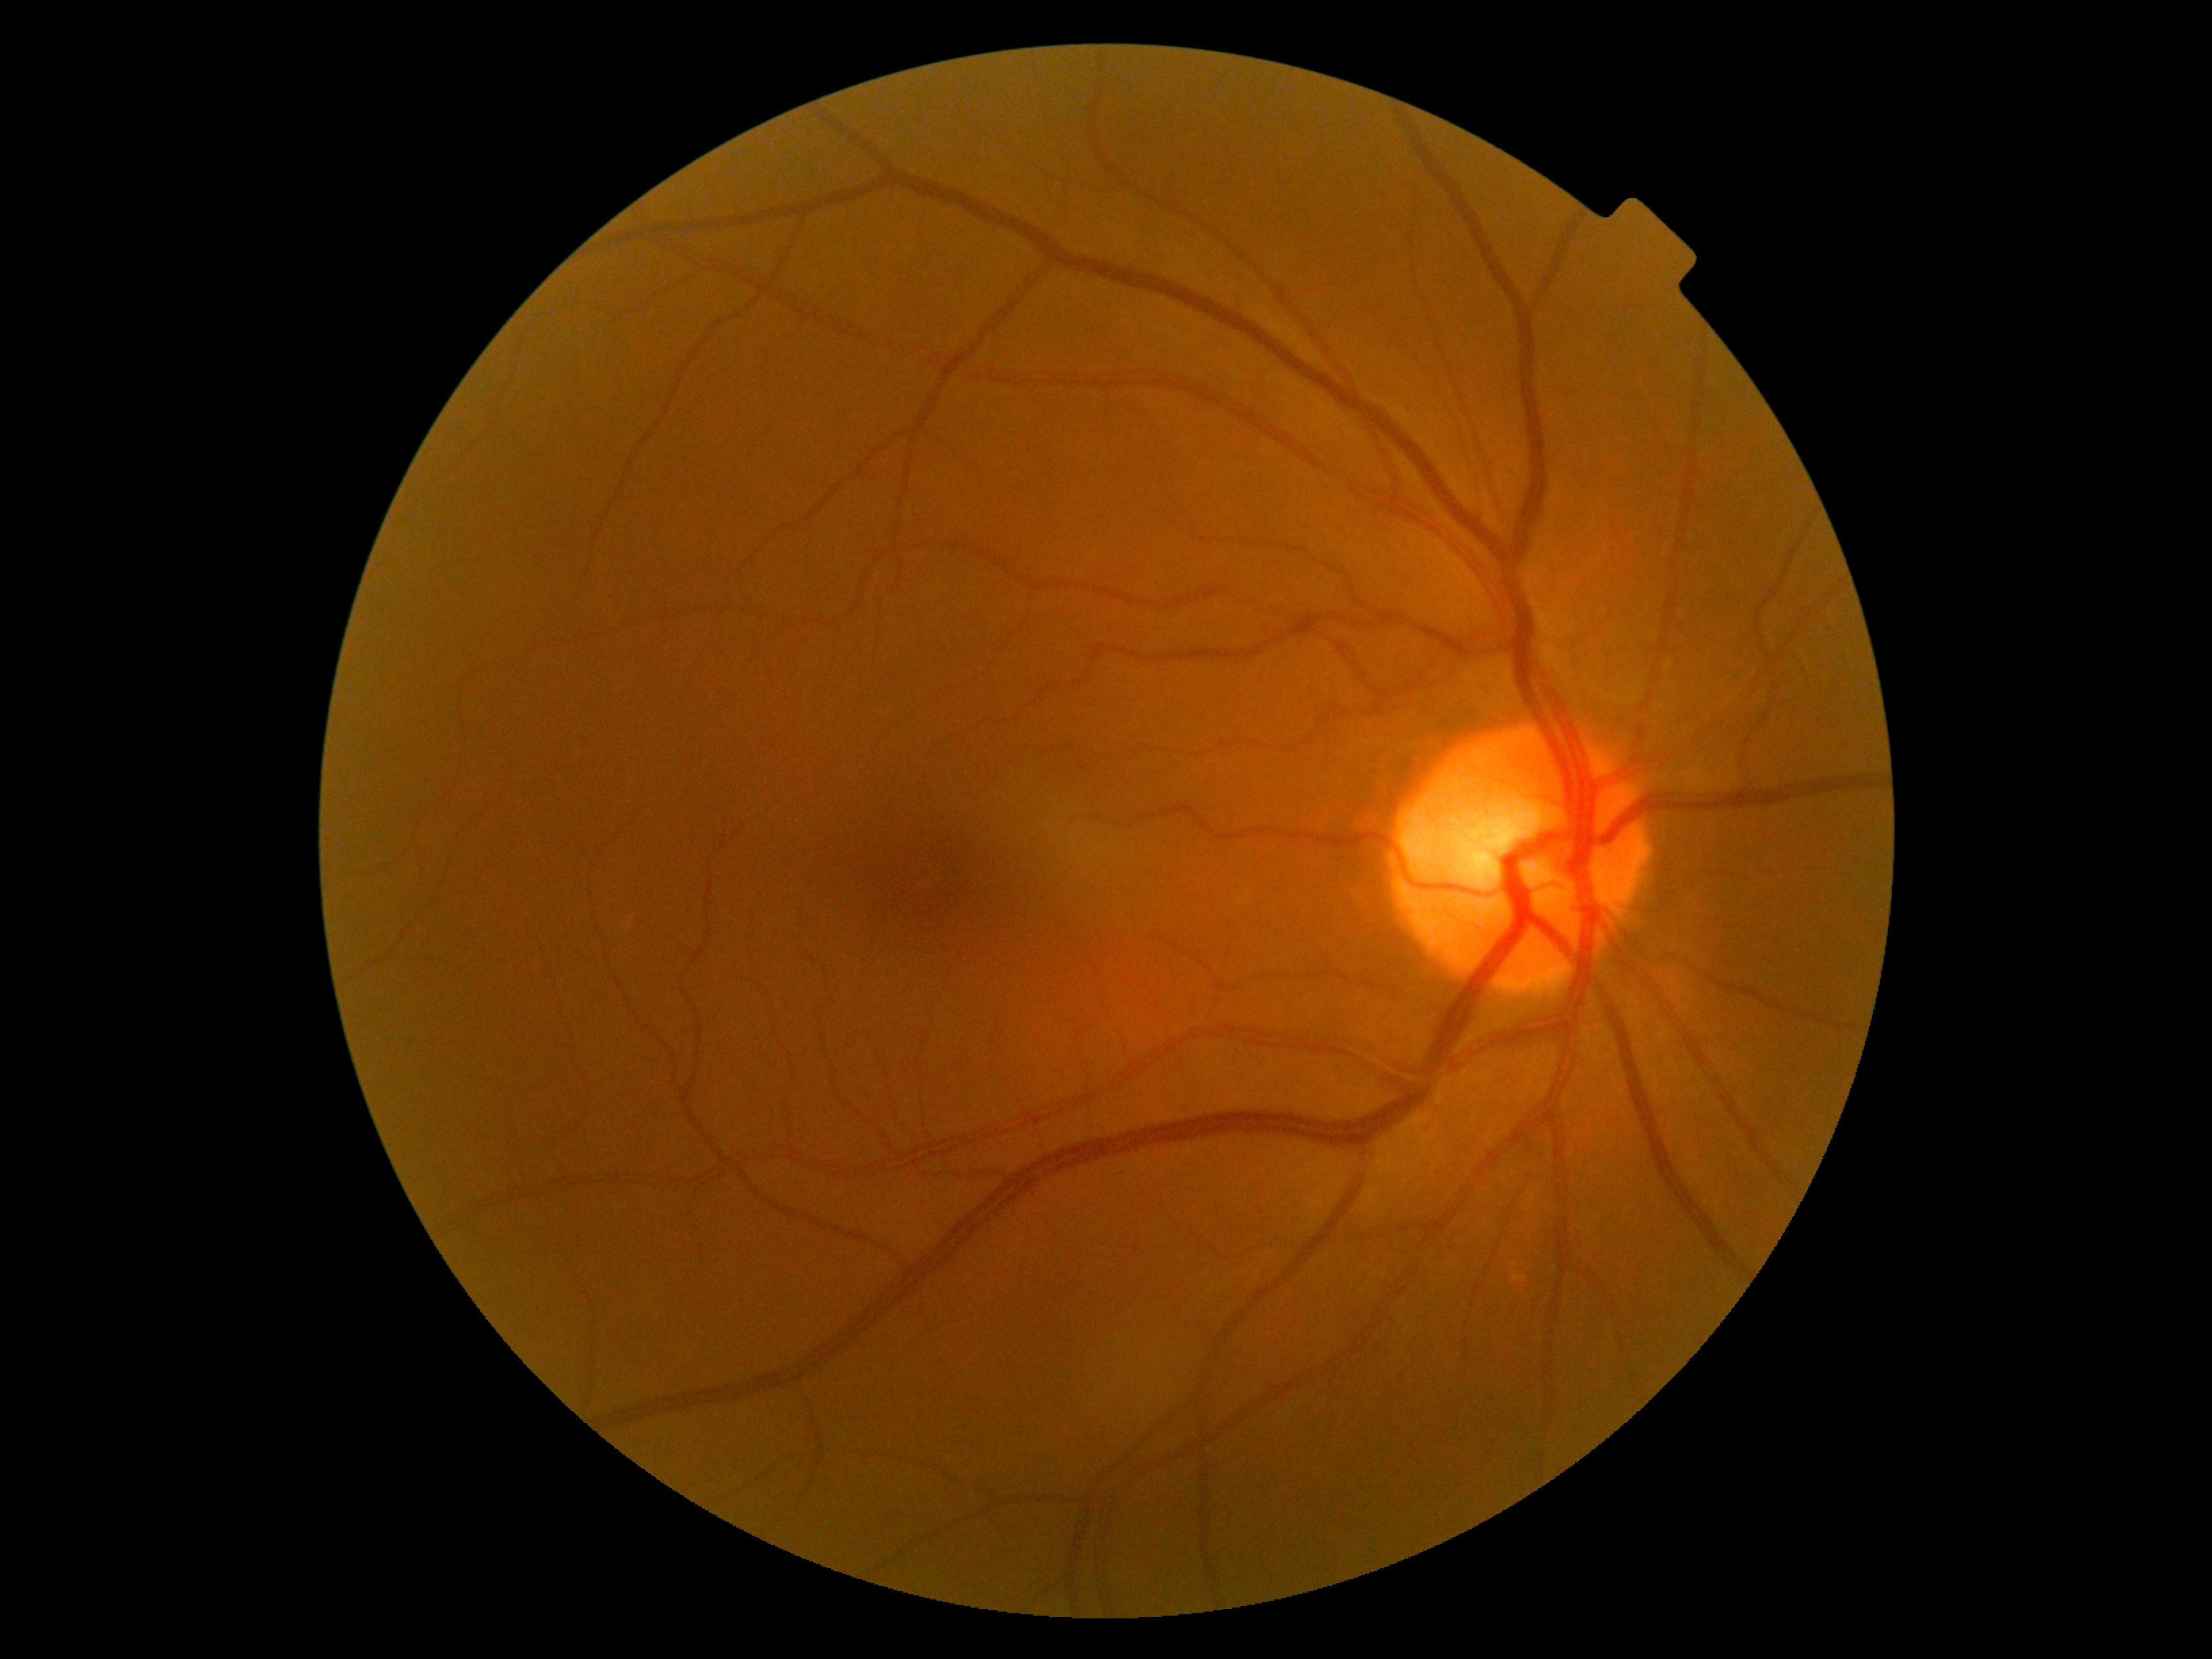
diabetic retinopathy (DR)=0 — no visible signs of diabetic retinopathy.